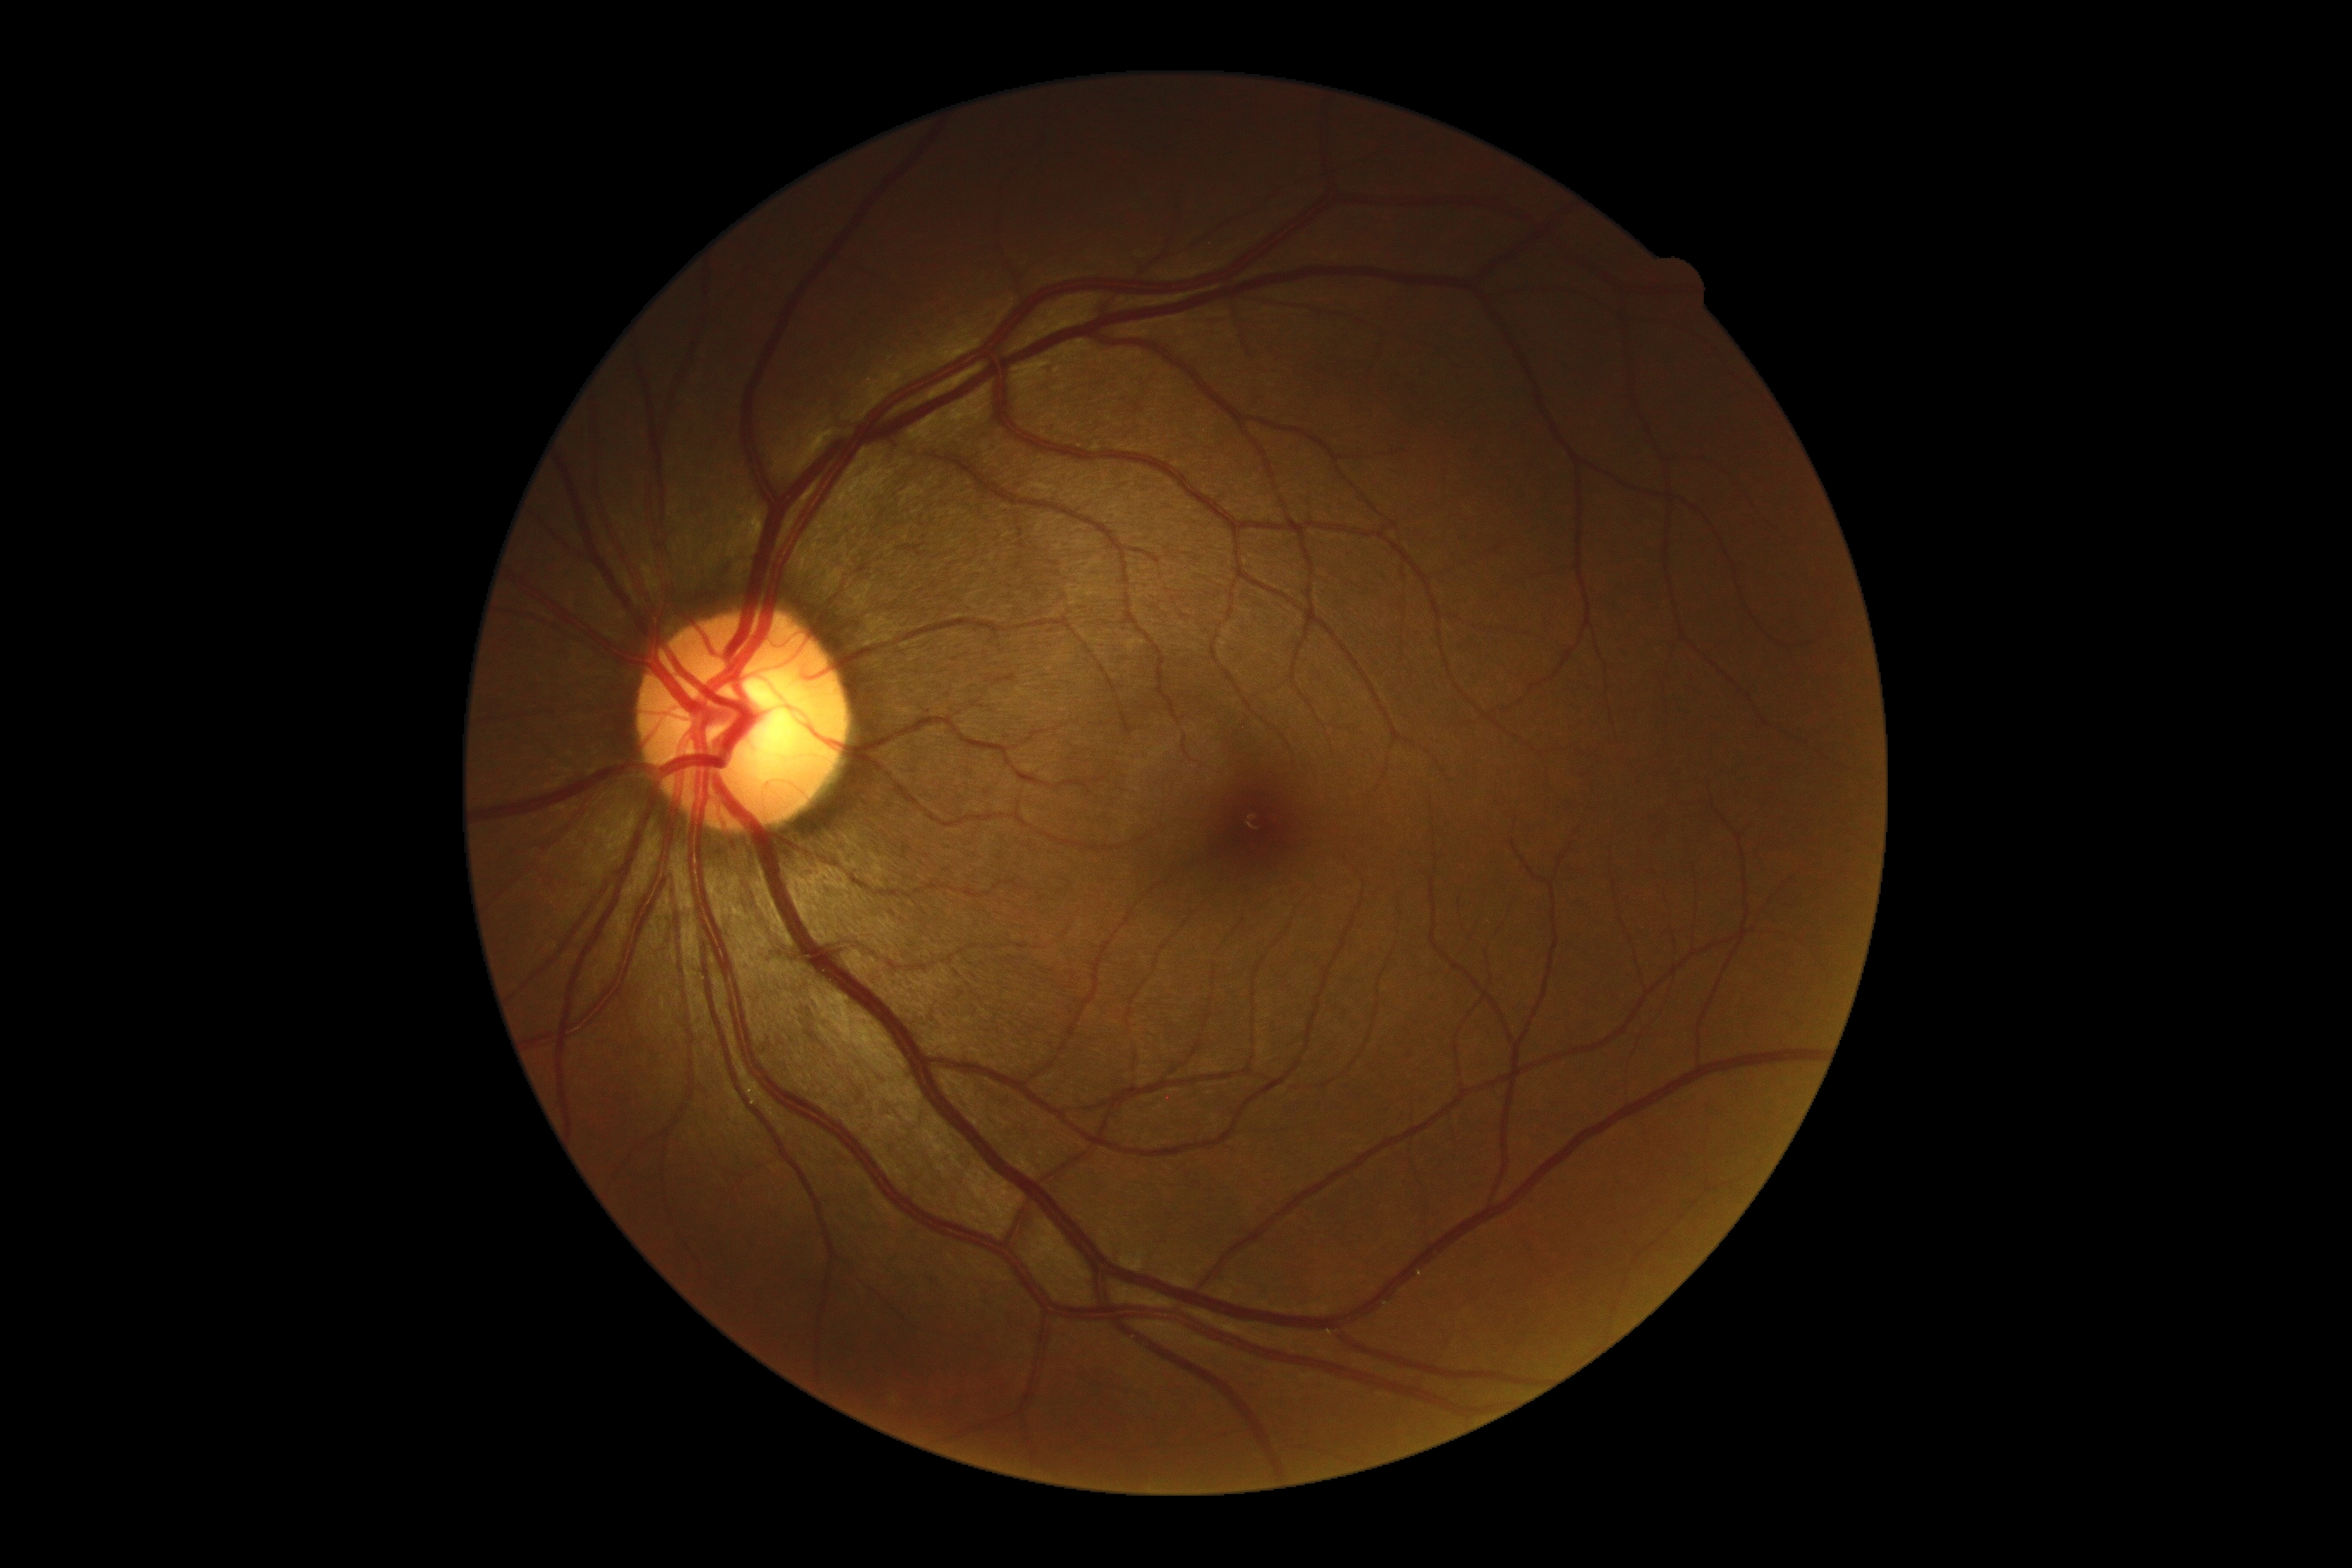

DR severity = grade 0